Fundus photo; image size 2352x1568; 45-degree field of view
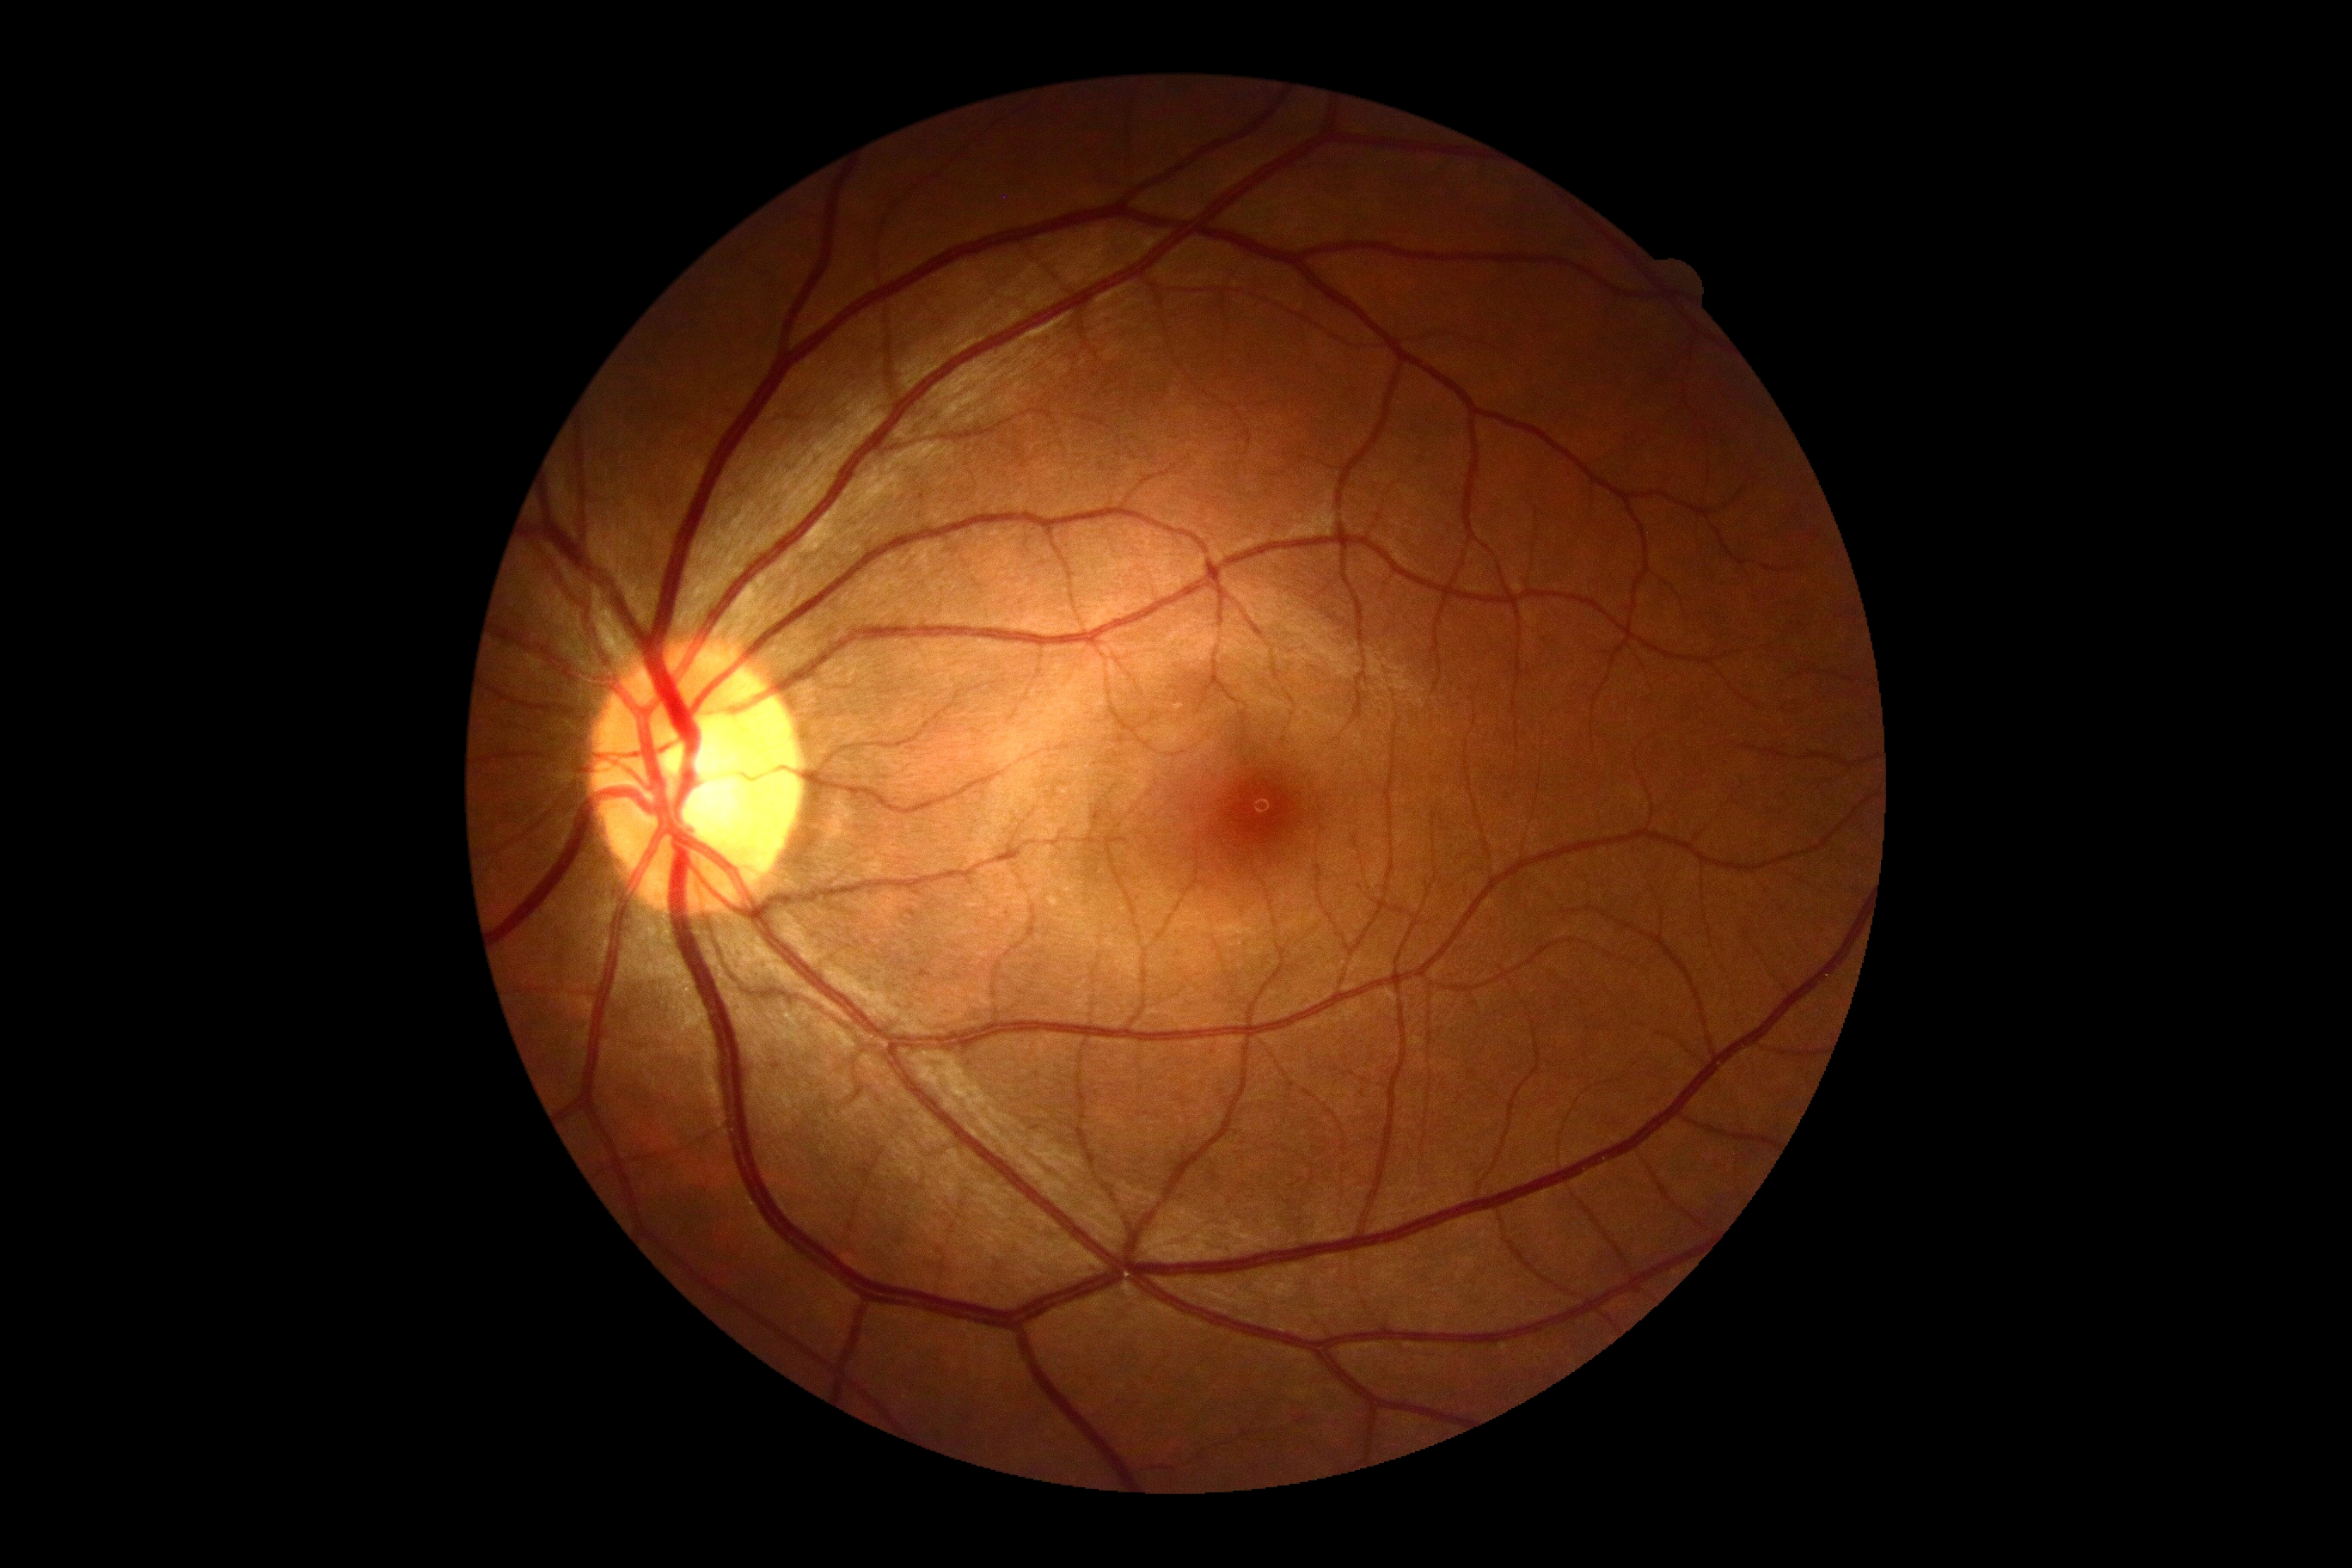
Findings:
* diabetic retinopathy grade: 0 (no apparent retinopathy)